130° field of view (Clarity RetCam 3); pediatric retinal photograph (wide-field)
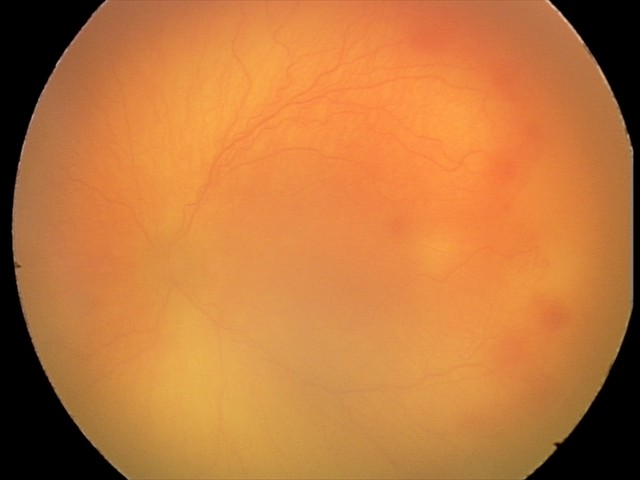

Diagnosis from this screening exam: aggressive retinopathy of prematurity (A-ROP). Plus disease present.